Camera: NIDEK AFC-230.
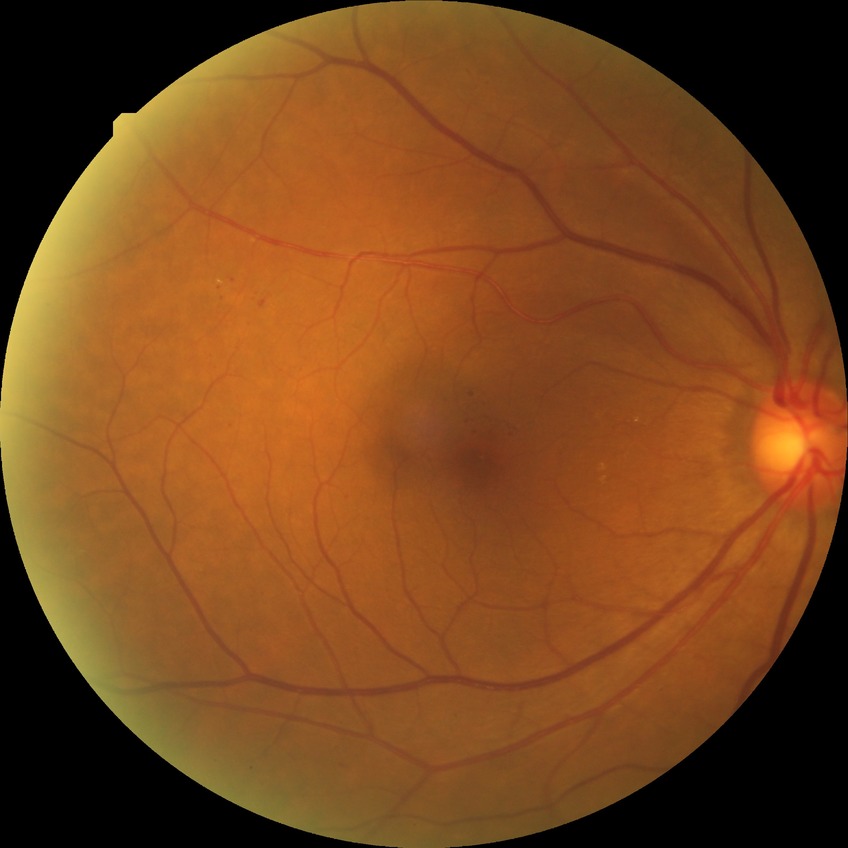

{
  "davis_grade": "simple diabetic retinopathy"
}